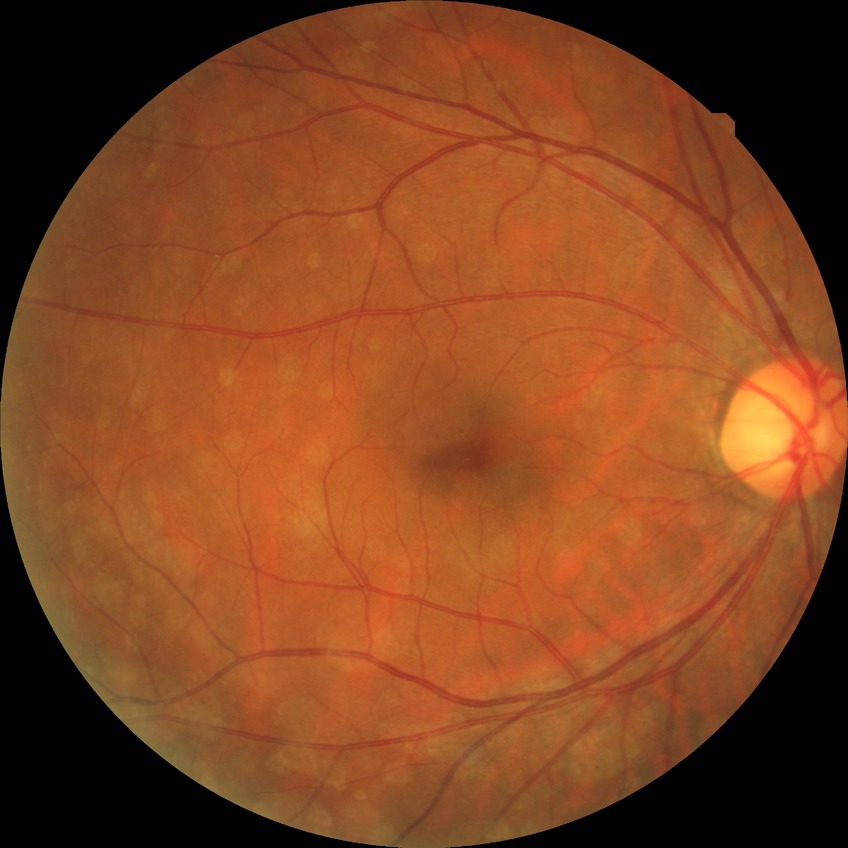 diabetic retinopathy (DR) = SDR (simple diabetic retinopathy).